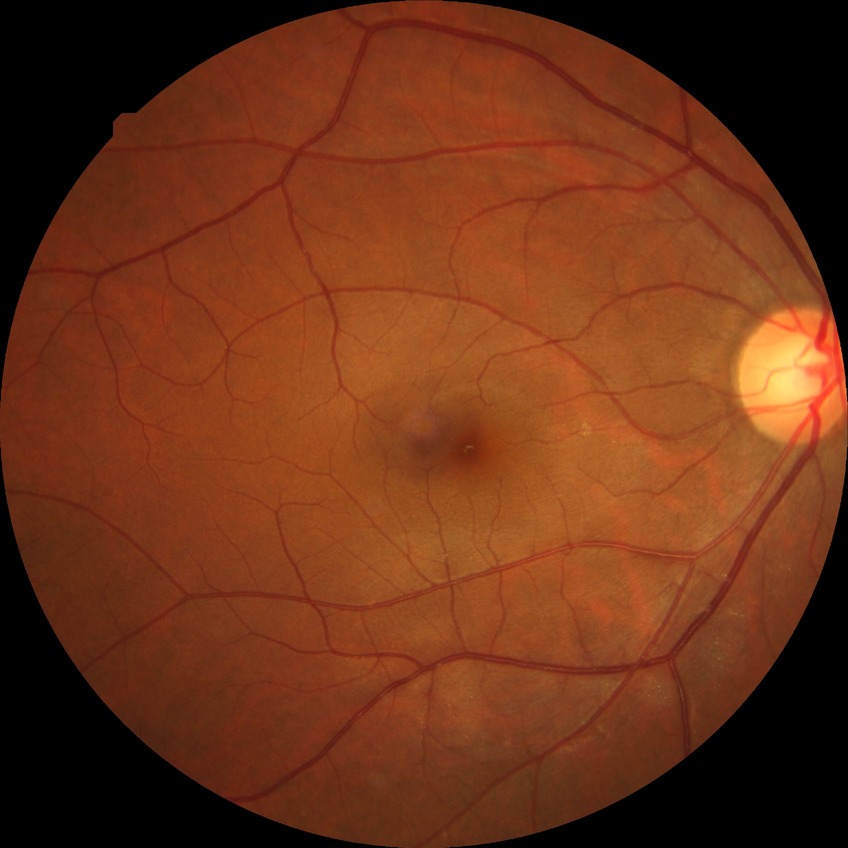

DR grade is NDR.